Nonmydriatic · diabetic retinopathy graded by the modified Davis classification — 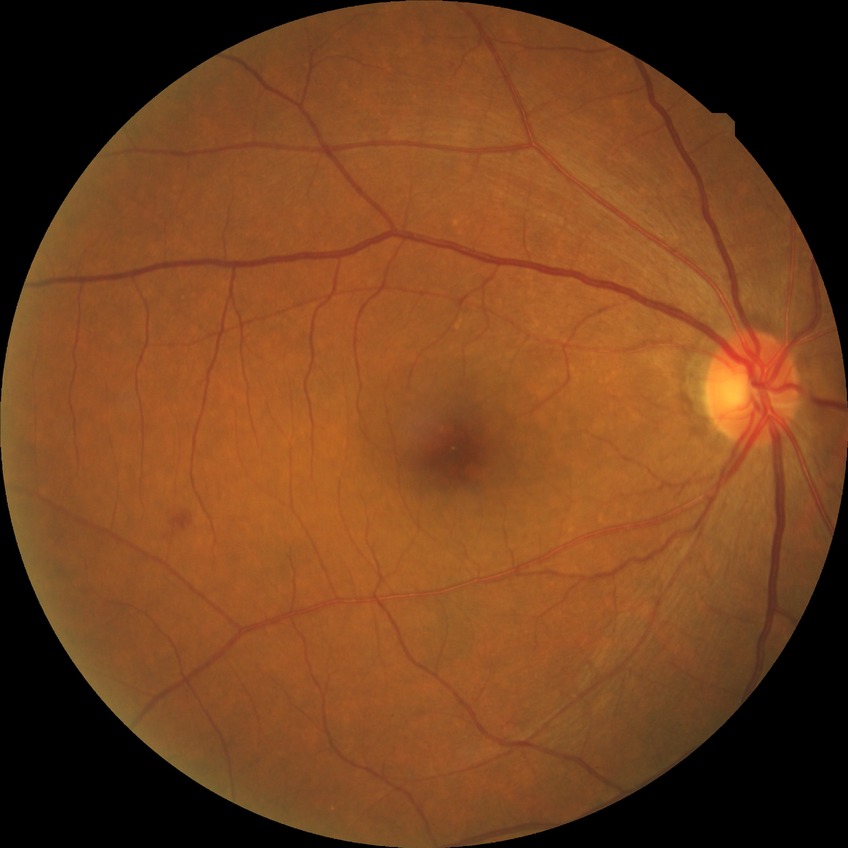 modified Davis grade: NDR
DR impression: no DR findings